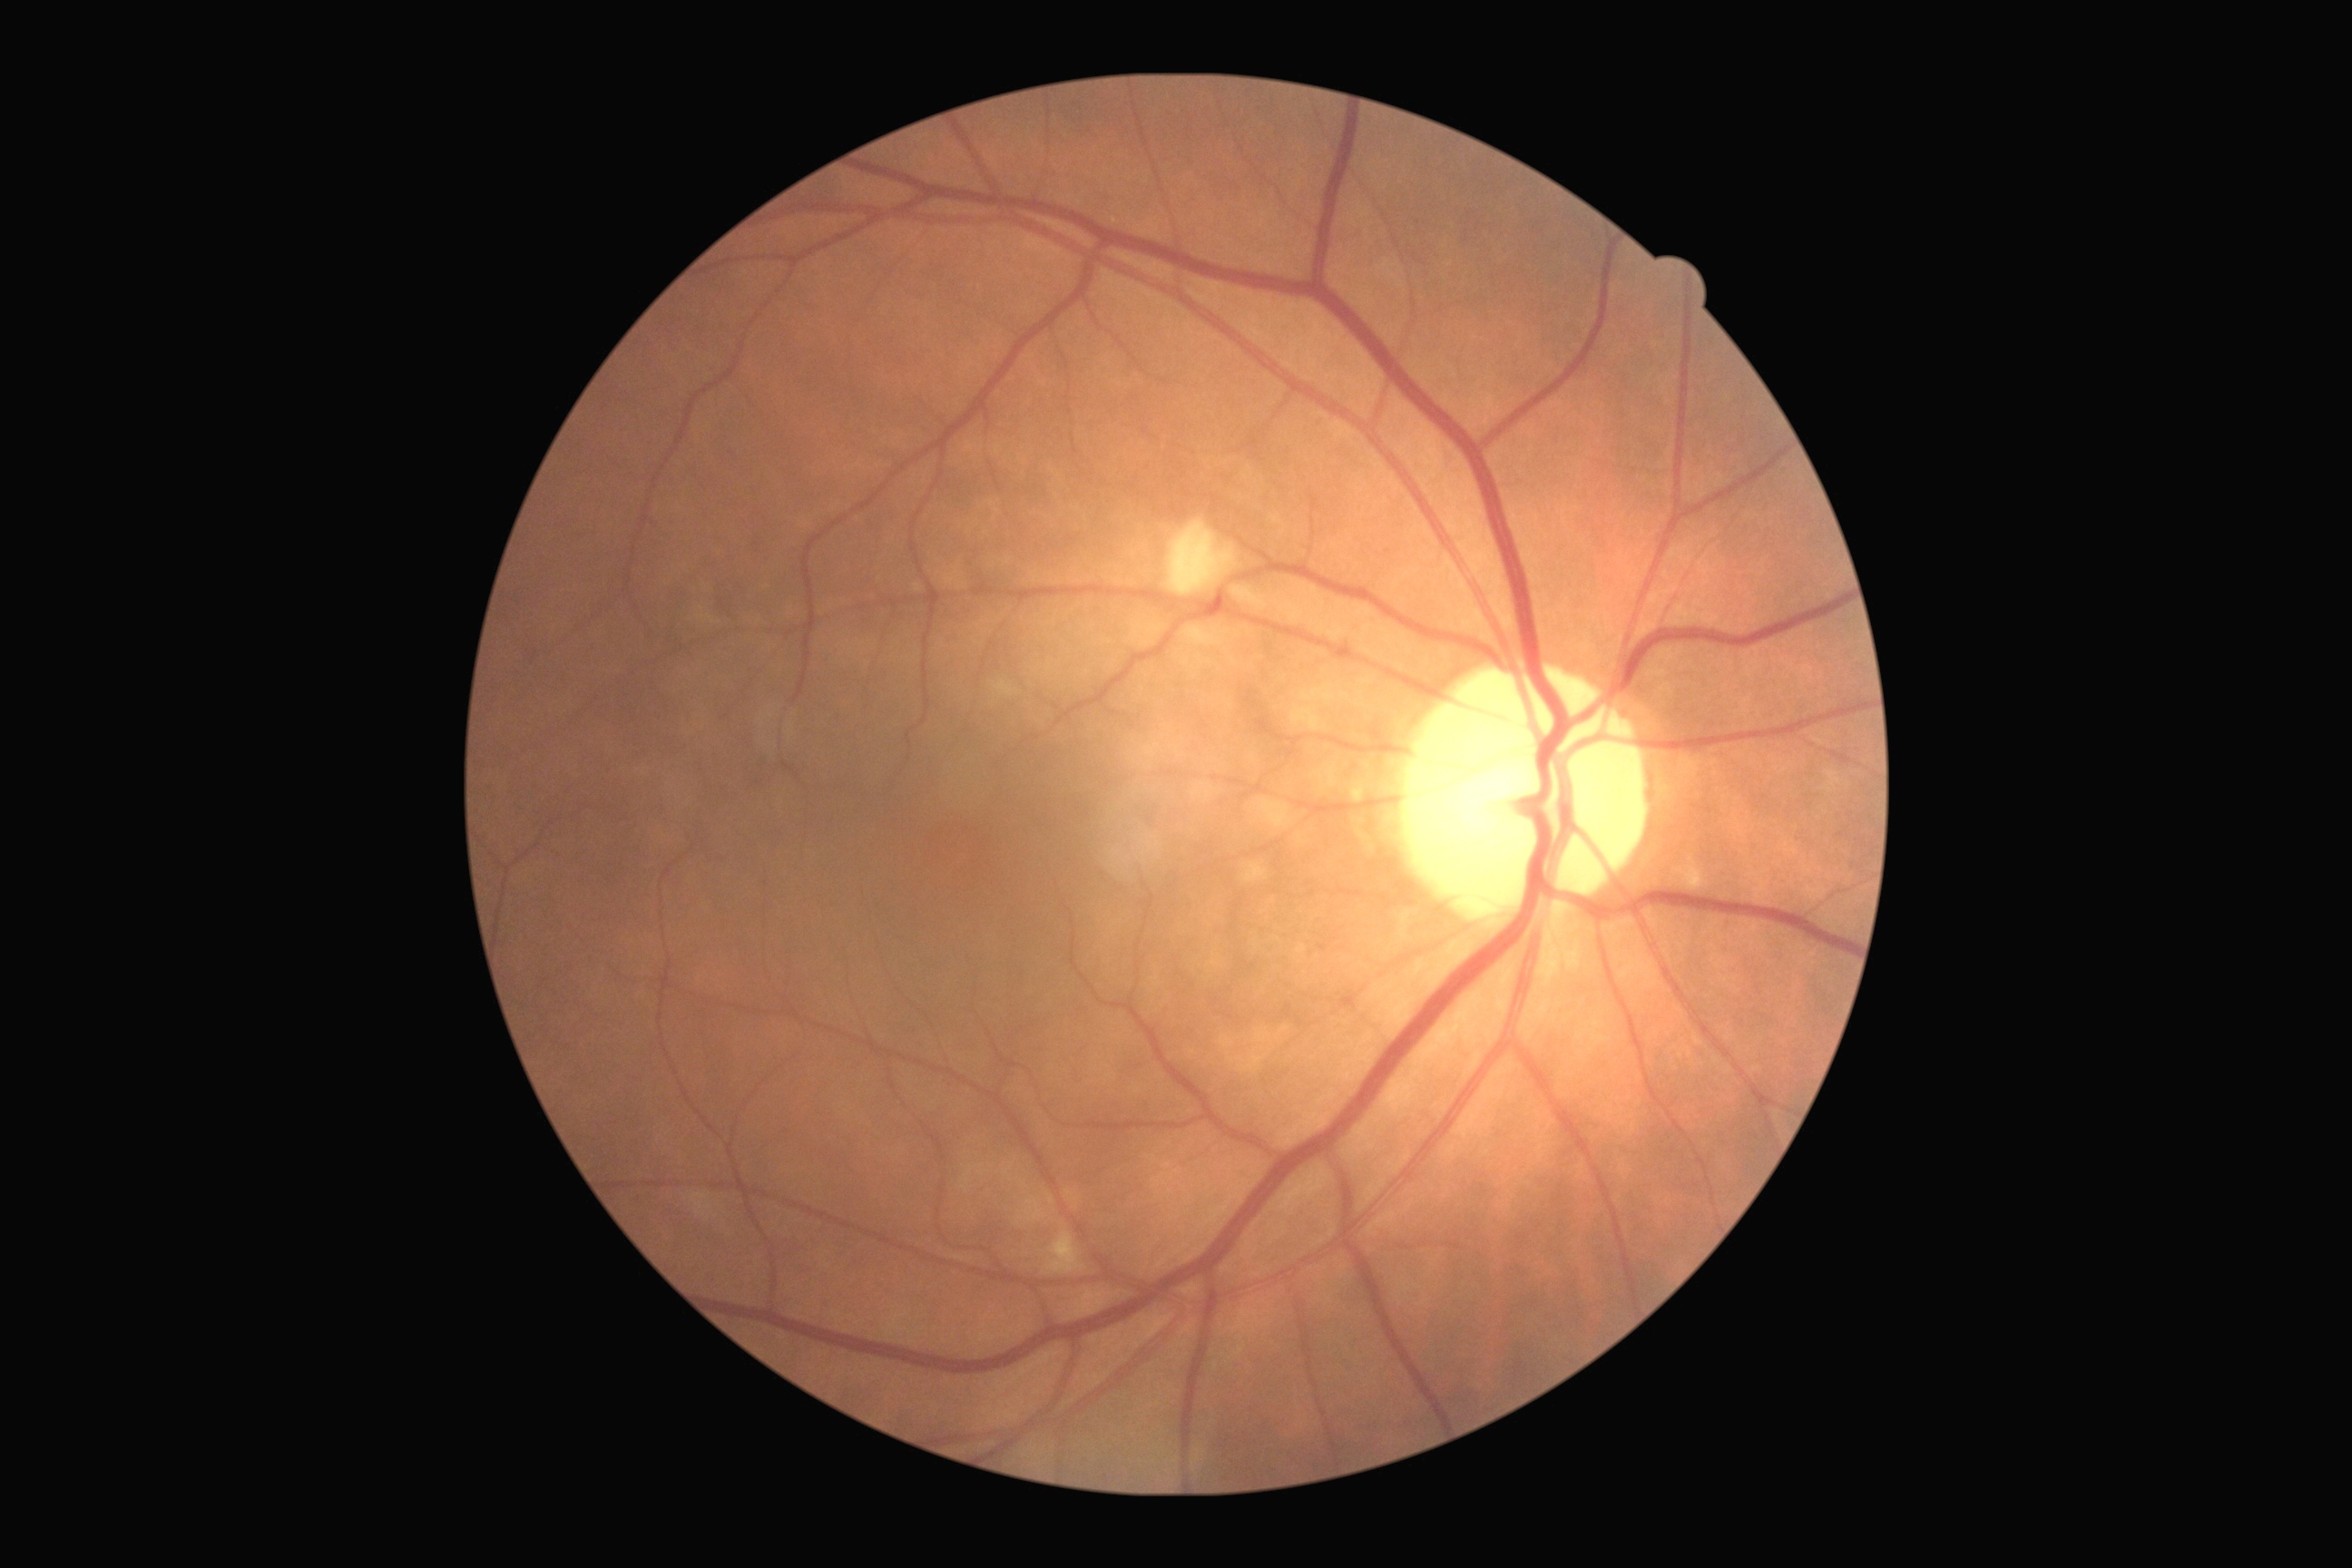
DR stage=moderate non-proliferative diabetic retinopathy (grade 2) — more than just microaneurysms but less than severe NPDR.